2352 by 1568 pixels.
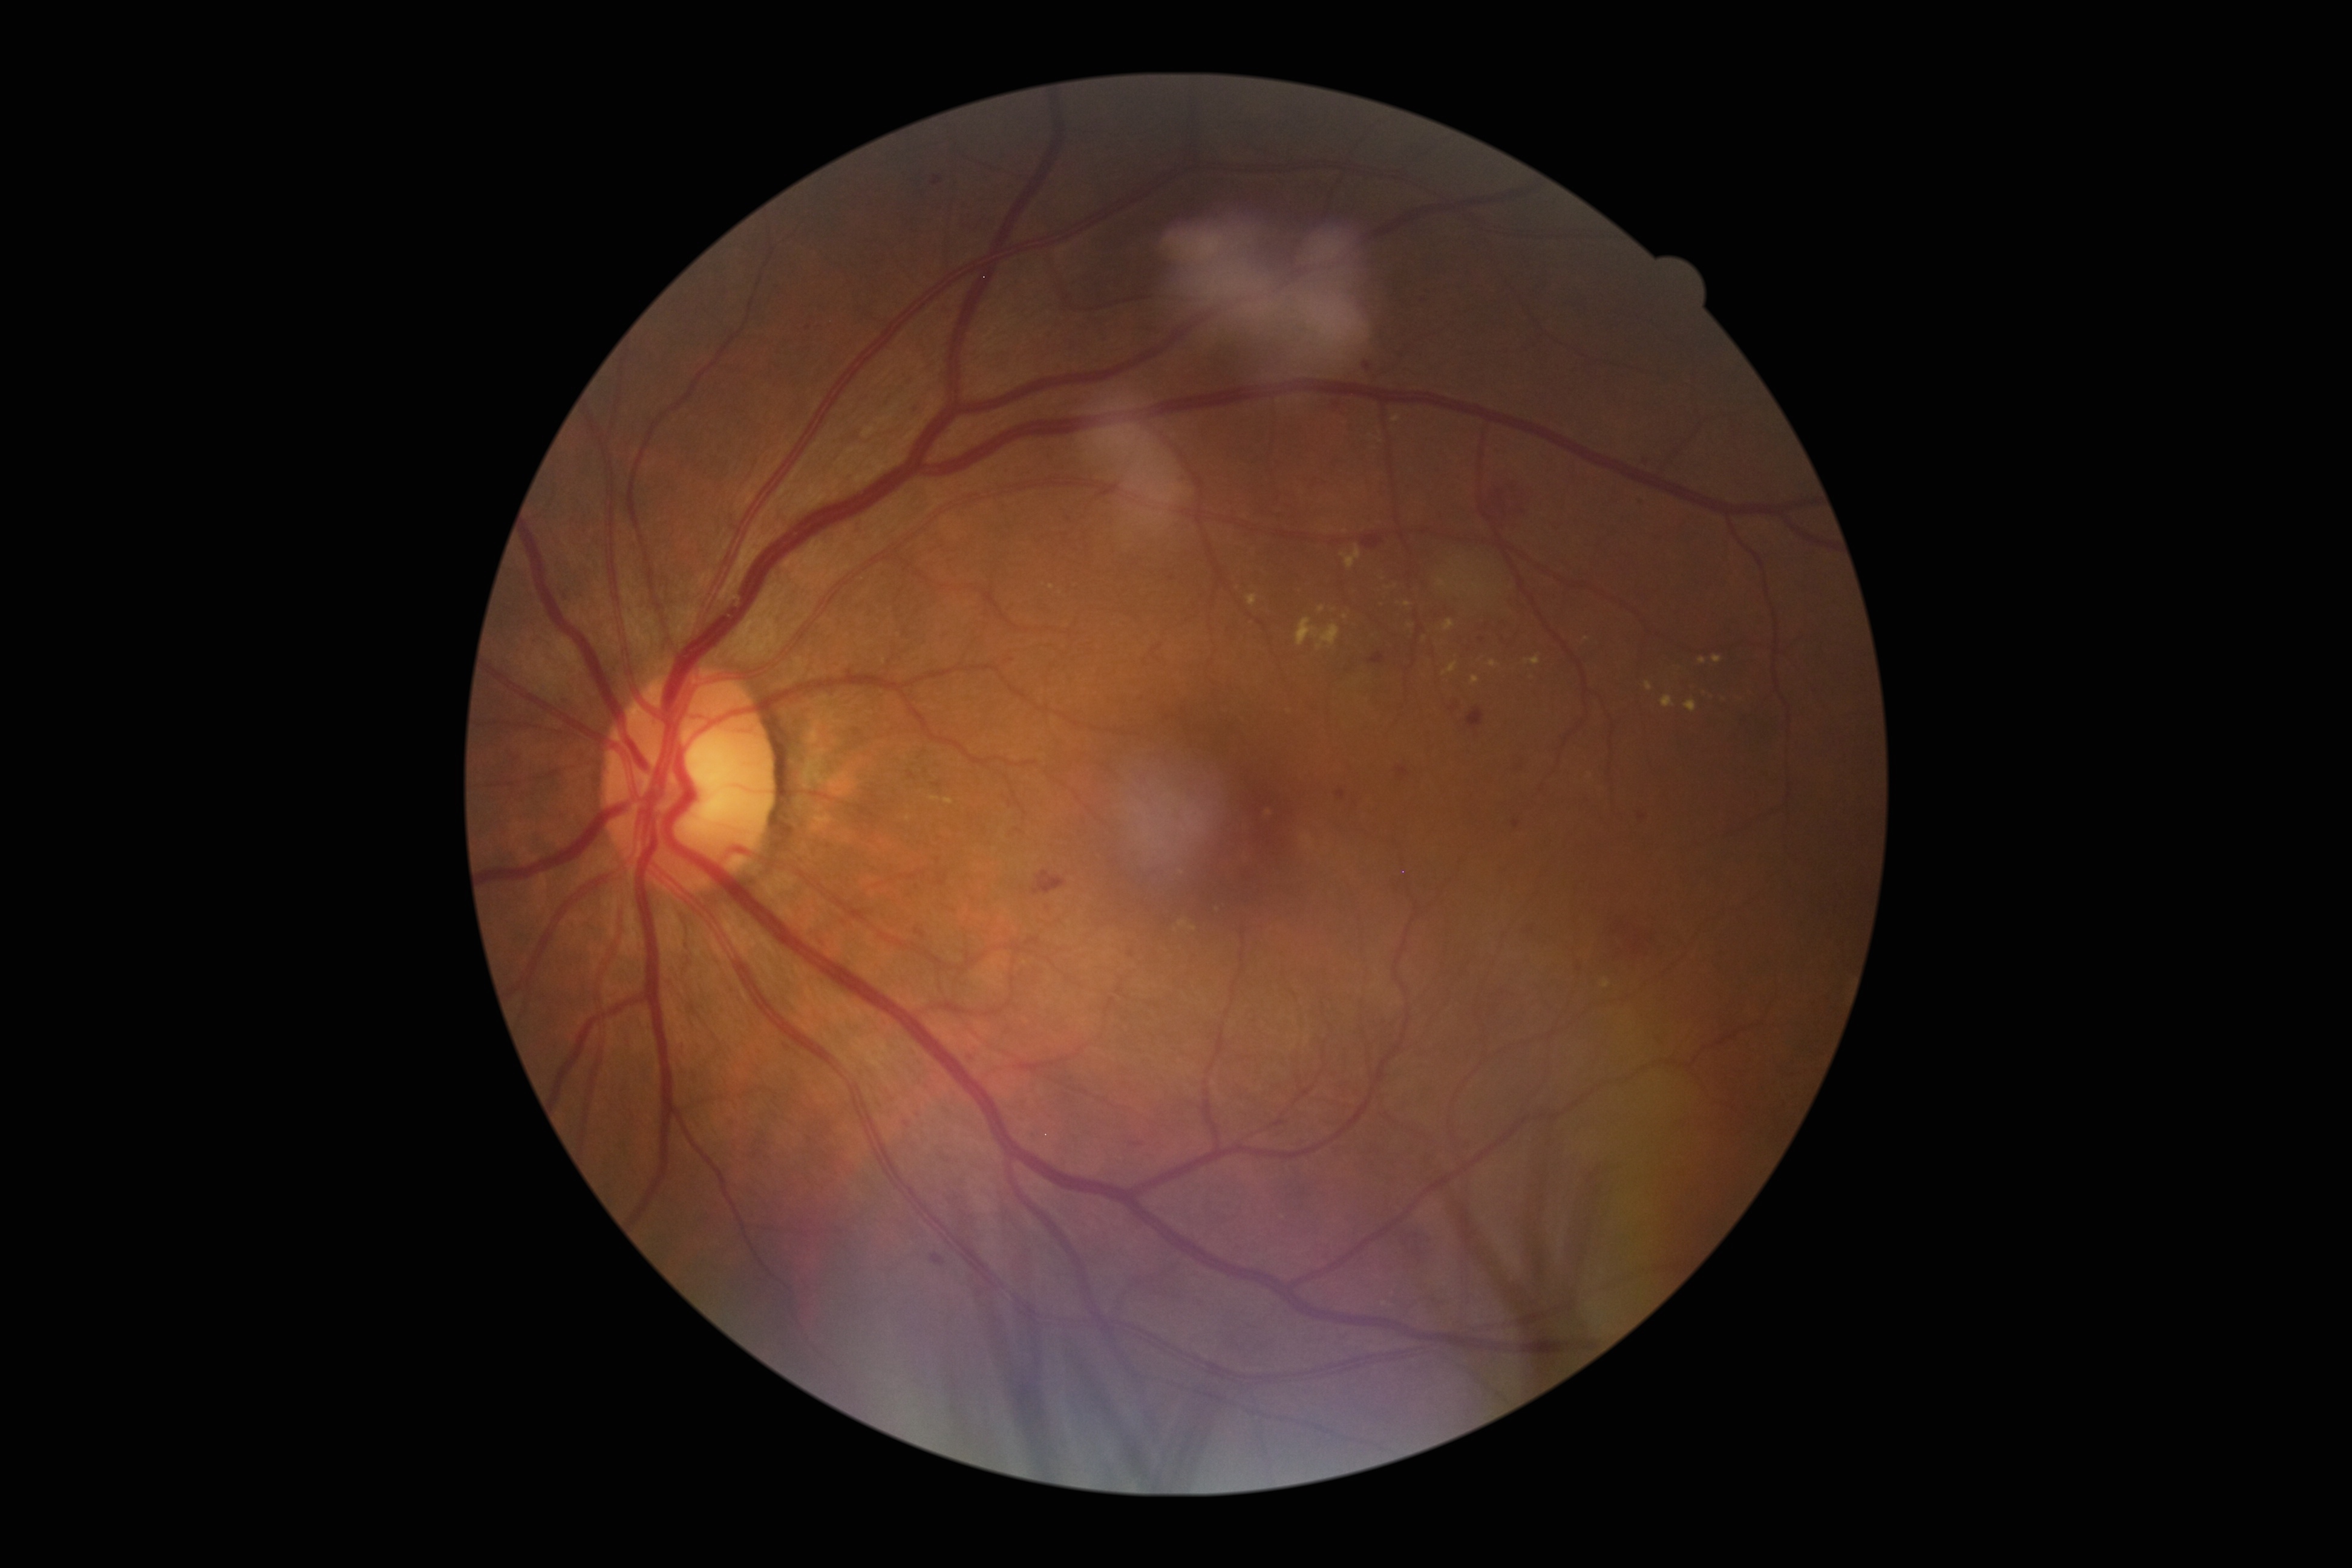

DR stage: moderate non-proliferative diabetic retinopathy (grade 2) — more than just microaneurysms but less than severe NPDR
Representative lesions:
HEs (subset): 1396,766,1411,780 | 1481,480,1535,541 | 1033,871,1068,896 | 1129,1142,1144,1146 | 557,584,577,603 | 1361,534,1385,549 | 903,1121,912,1128 | 684,1065,700,1081 | 1639,453,1658,474 | 933,782,942,787 | 931,1253,946,1265 | 1361,353,1379,378 | 1006,659,1014,662 | 1336,789,1346,800
HEs (small, approximate centers) near [x=1532, y=929] | [x=1048, y=907] | [x=1482, y=640]
EXs (subset): 1662,695,1675,708 | 1698,658,1707,665 | 944,798,954,804 | 1437,579,1449,590 | 1471,676,1479,685 | 1247,593,1258,607 | 1392,416,1402,423 | 1471,583,1484,595 | 1340,546,1361,569
EXs (small, approximate centers) near [x=1389, y=588] | [x=1345, y=531] | [x=1321, y=610] | [x=1586, y=639] | [x=1346, y=617] | [x=1407, y=604]